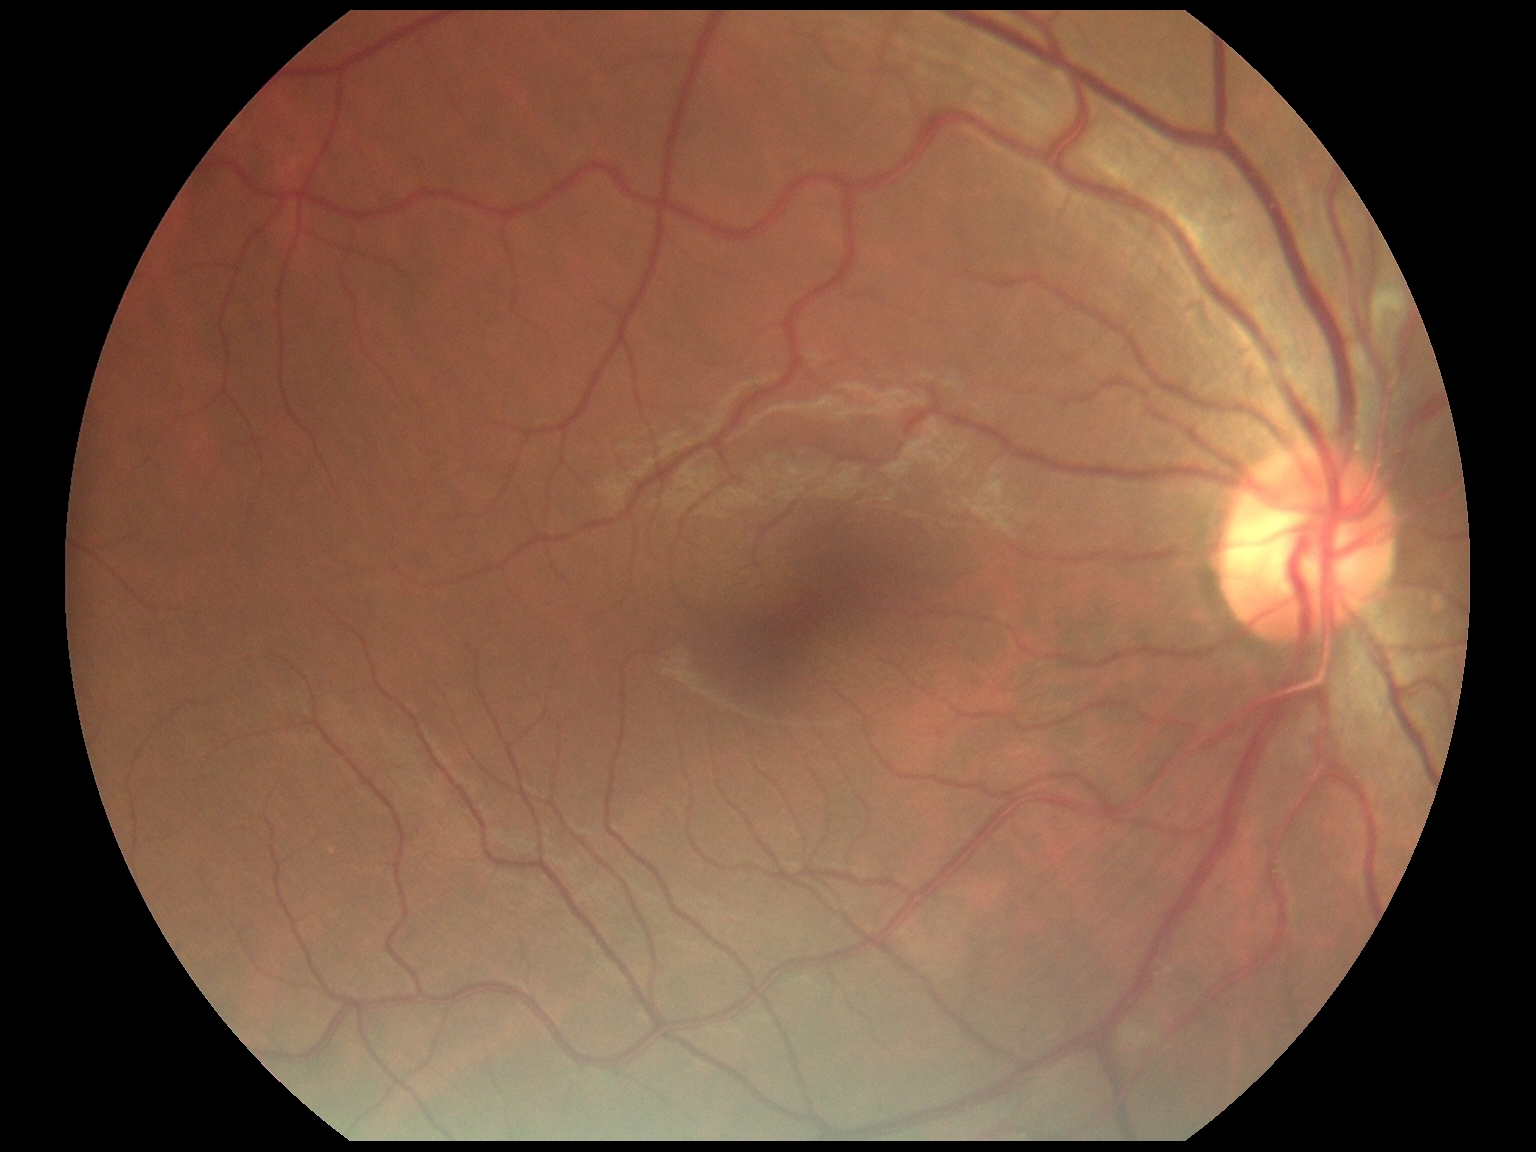
diabetic retinopathy (DR): 0, DR impression: no signs of DR.